FOV: 45 degrees.
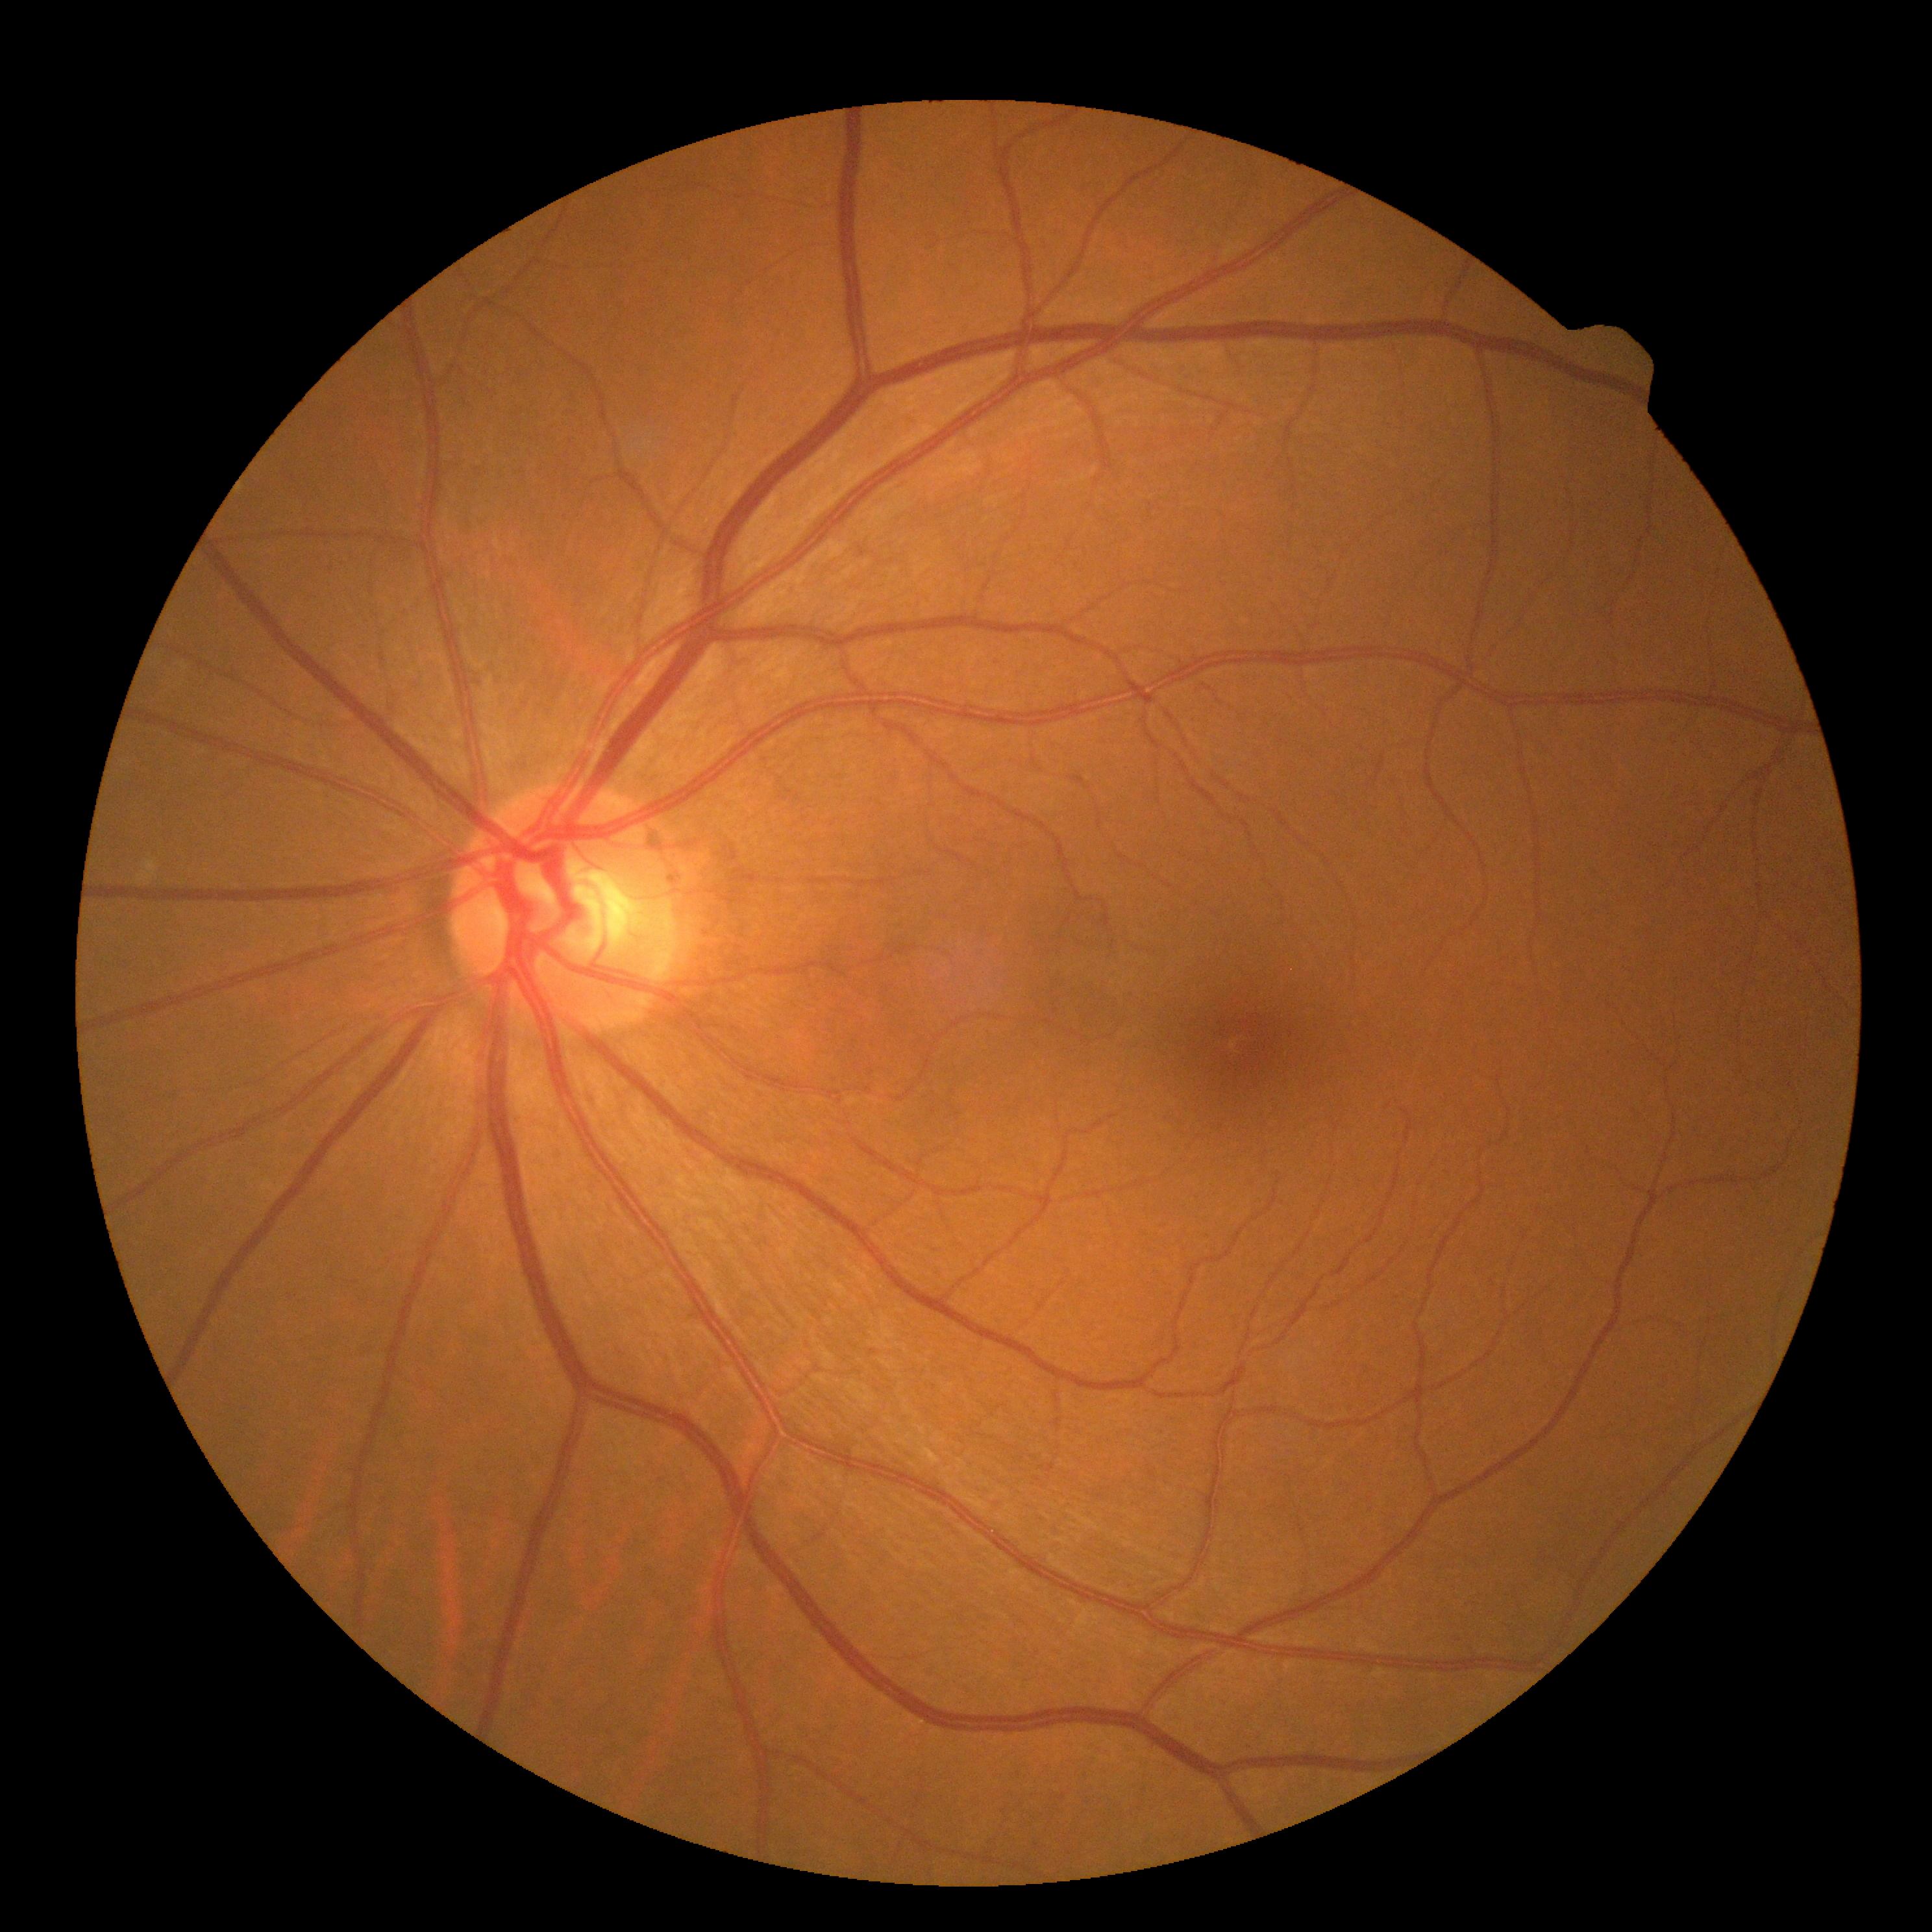
Diabetic retinopathy (DR) is grade 0. No signs of diabetic retinopathy.